CFP
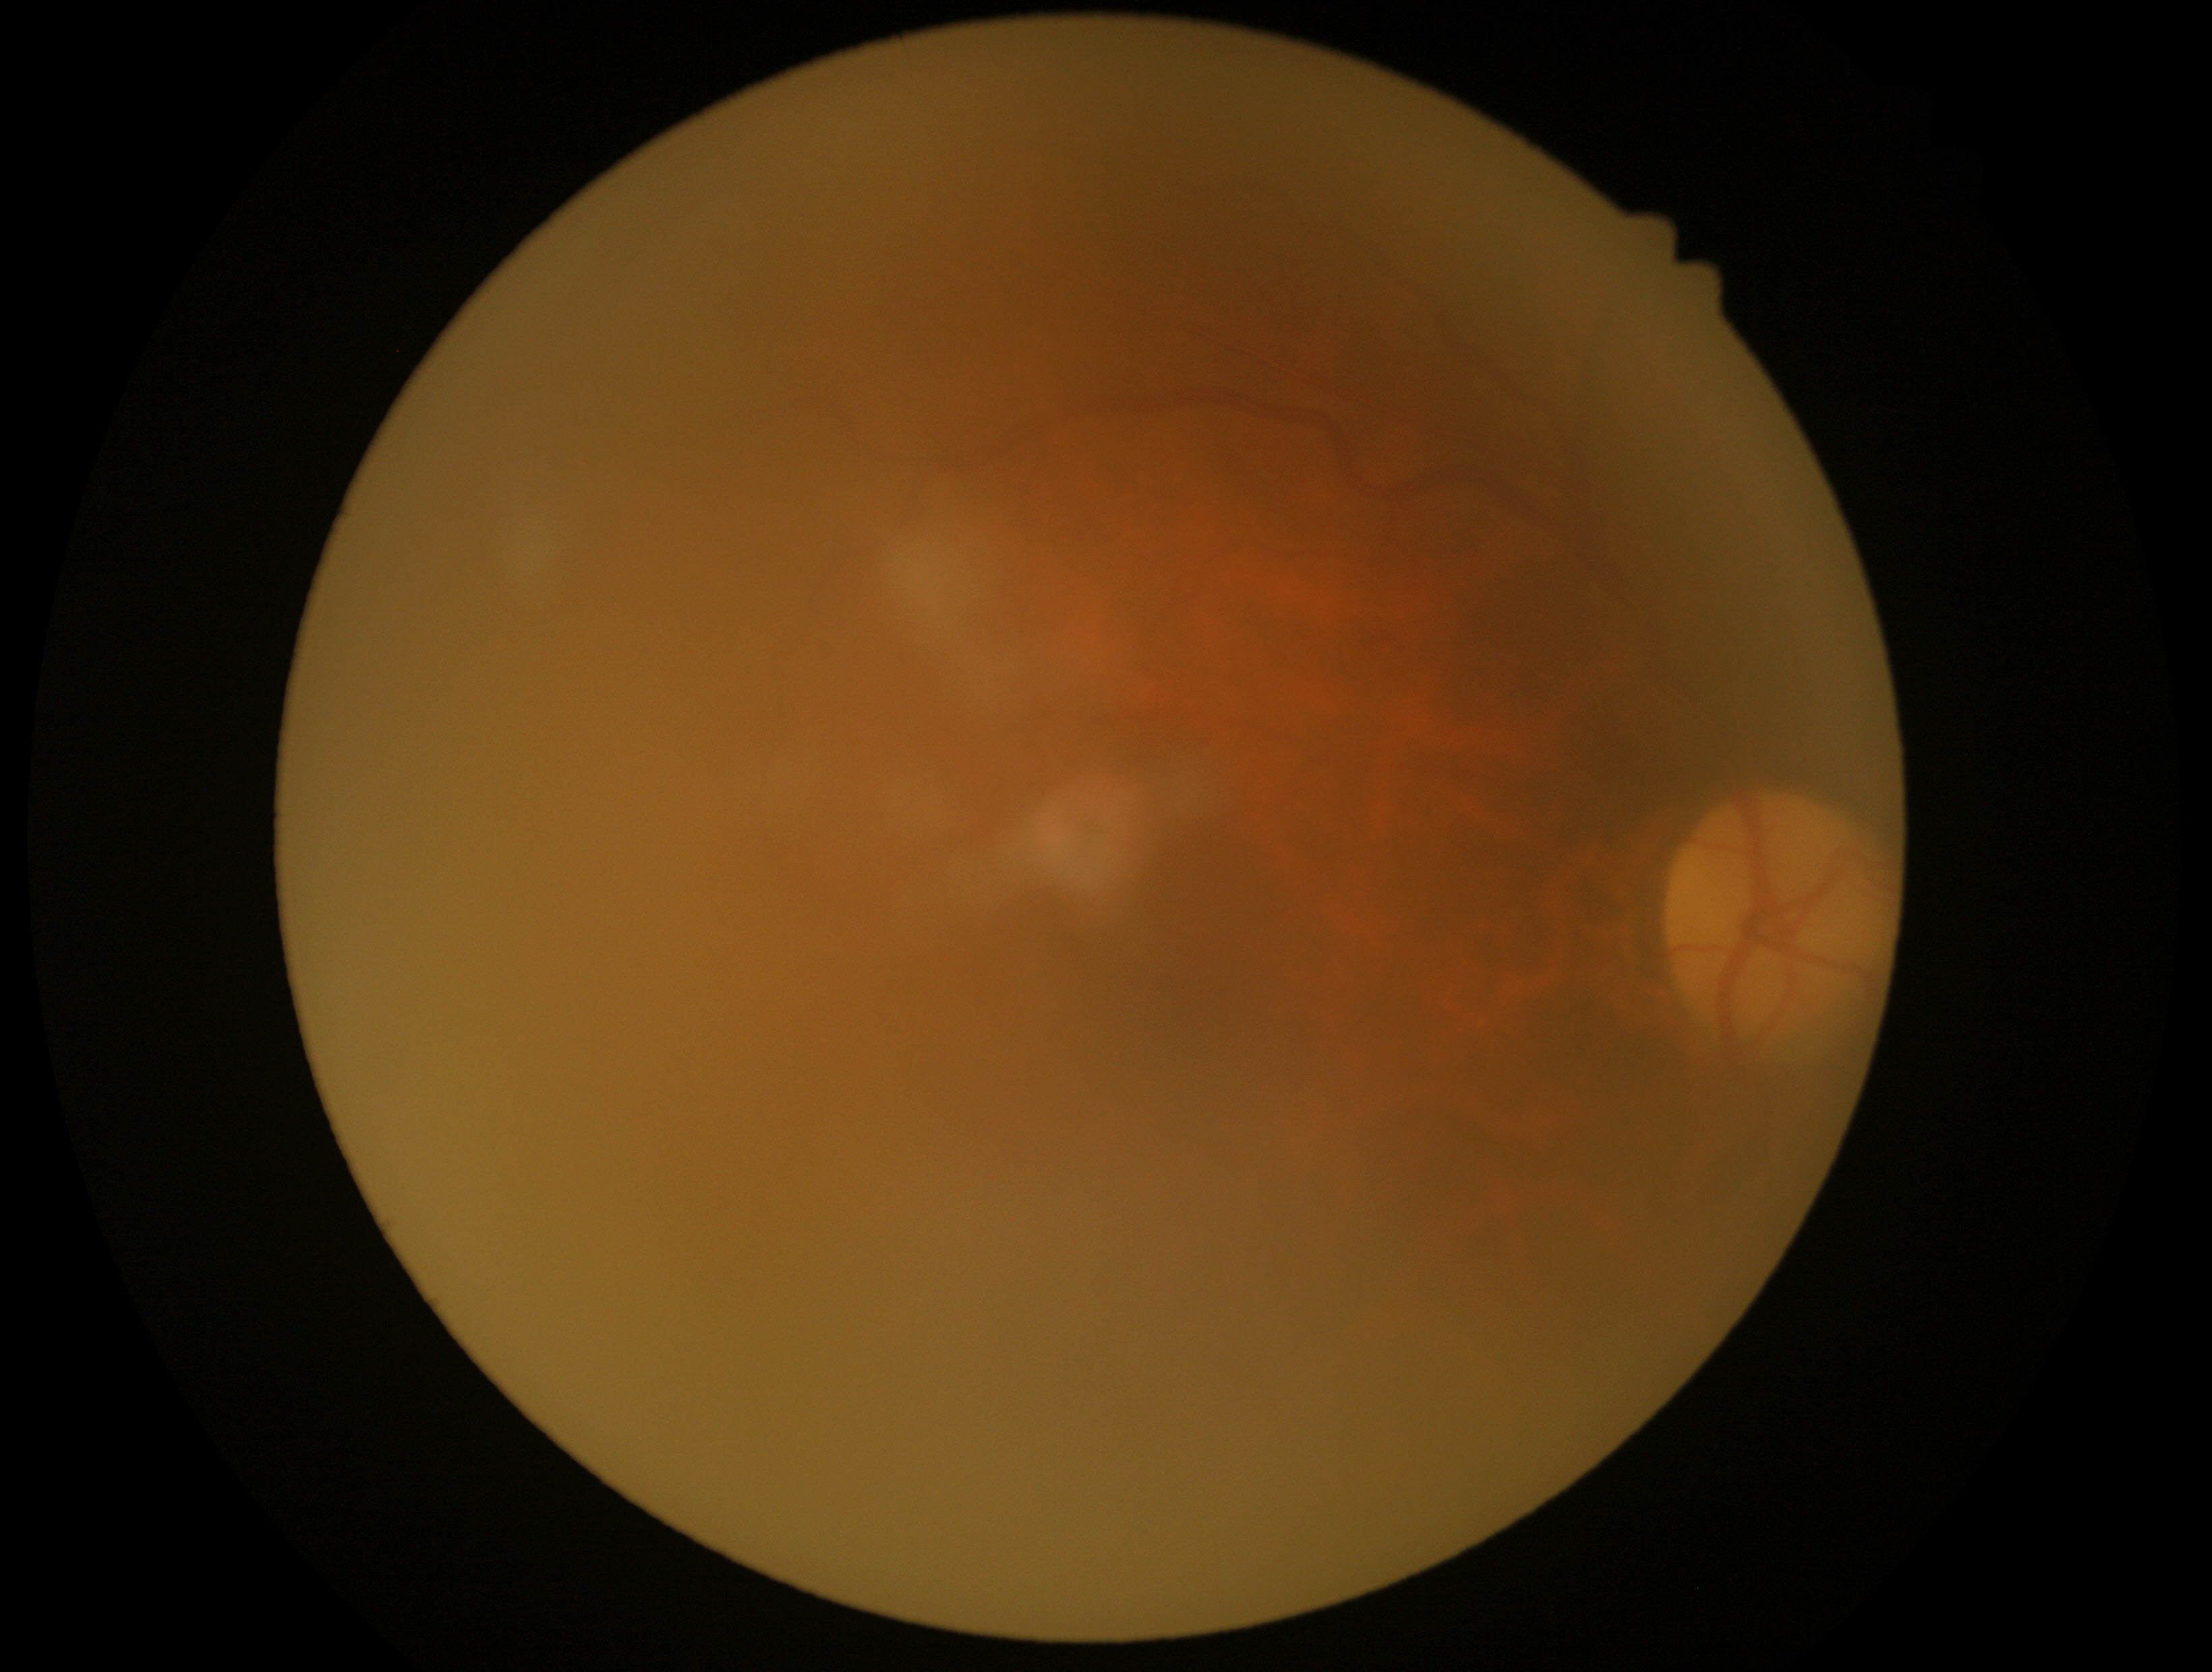 Diabetic retinopathy (DR) is ungradable due to poor image quality. Quality too poor to assess for DR.